Without pupil dilation. Acquired with a NIDEK AFC-230. 848 x 848 pixels. Posterior pole photograph:
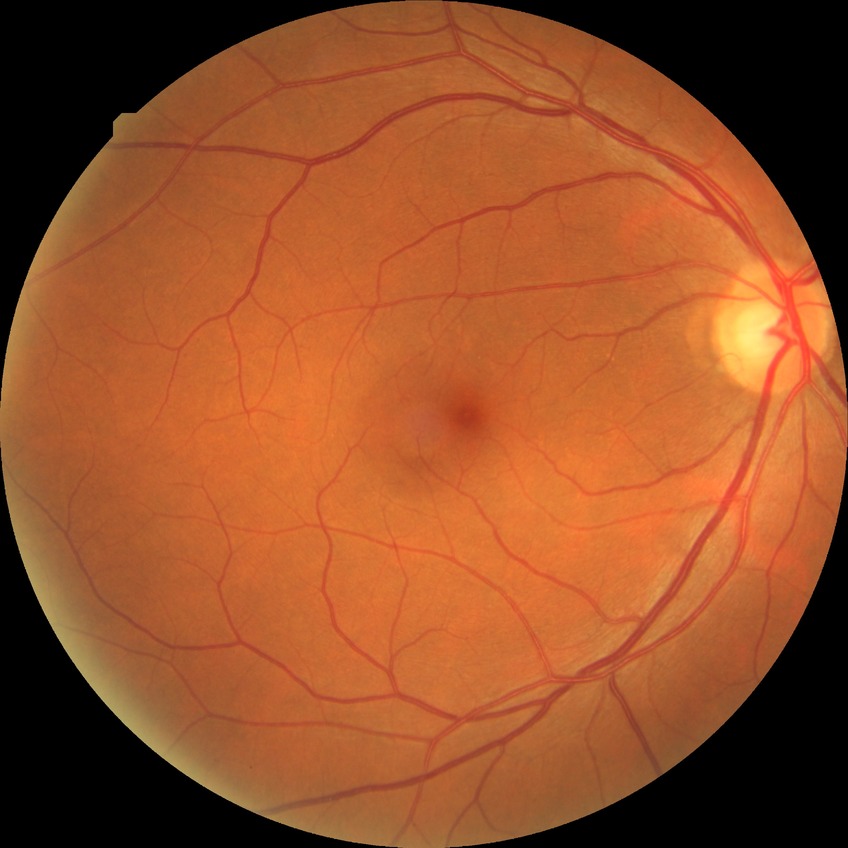 diabetic retinopathy grade=no diabetic retinopathy.